Fundus photo. Image size 2212x1659 — 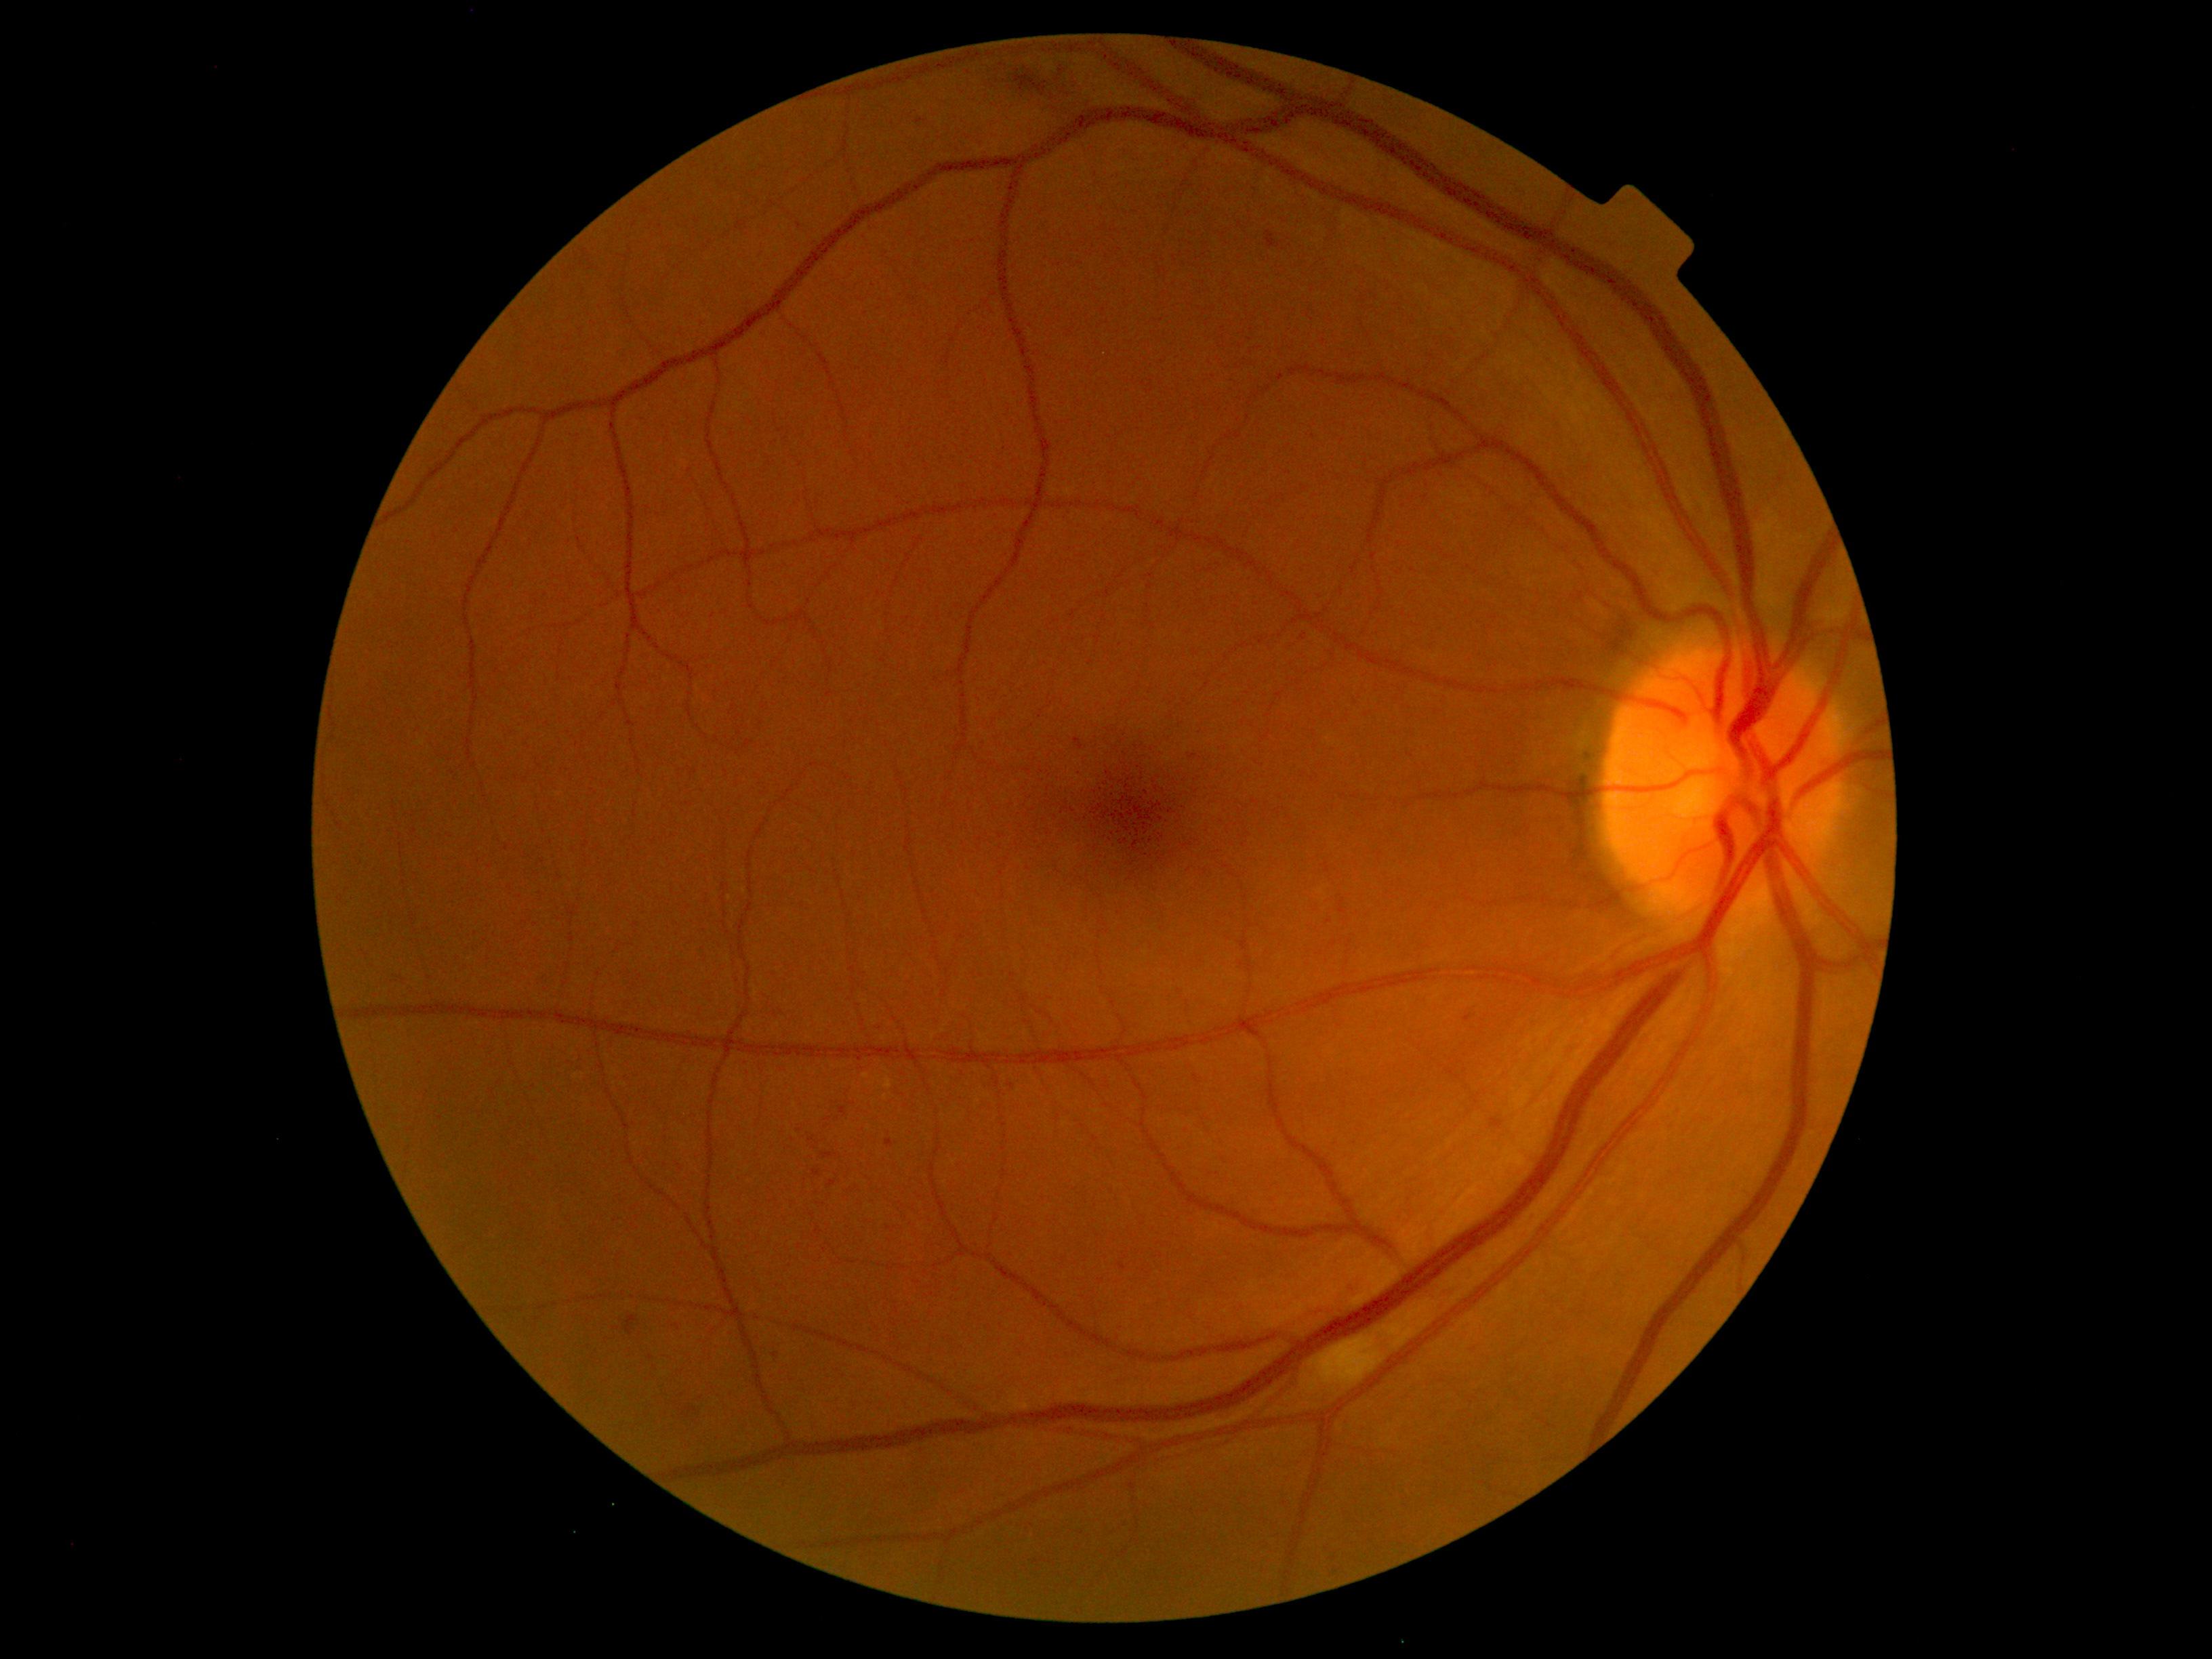

DR=moderate NPDR (grade 2); DR class=non-proliferative diabetic retinopathy.